Pupil-dilated.
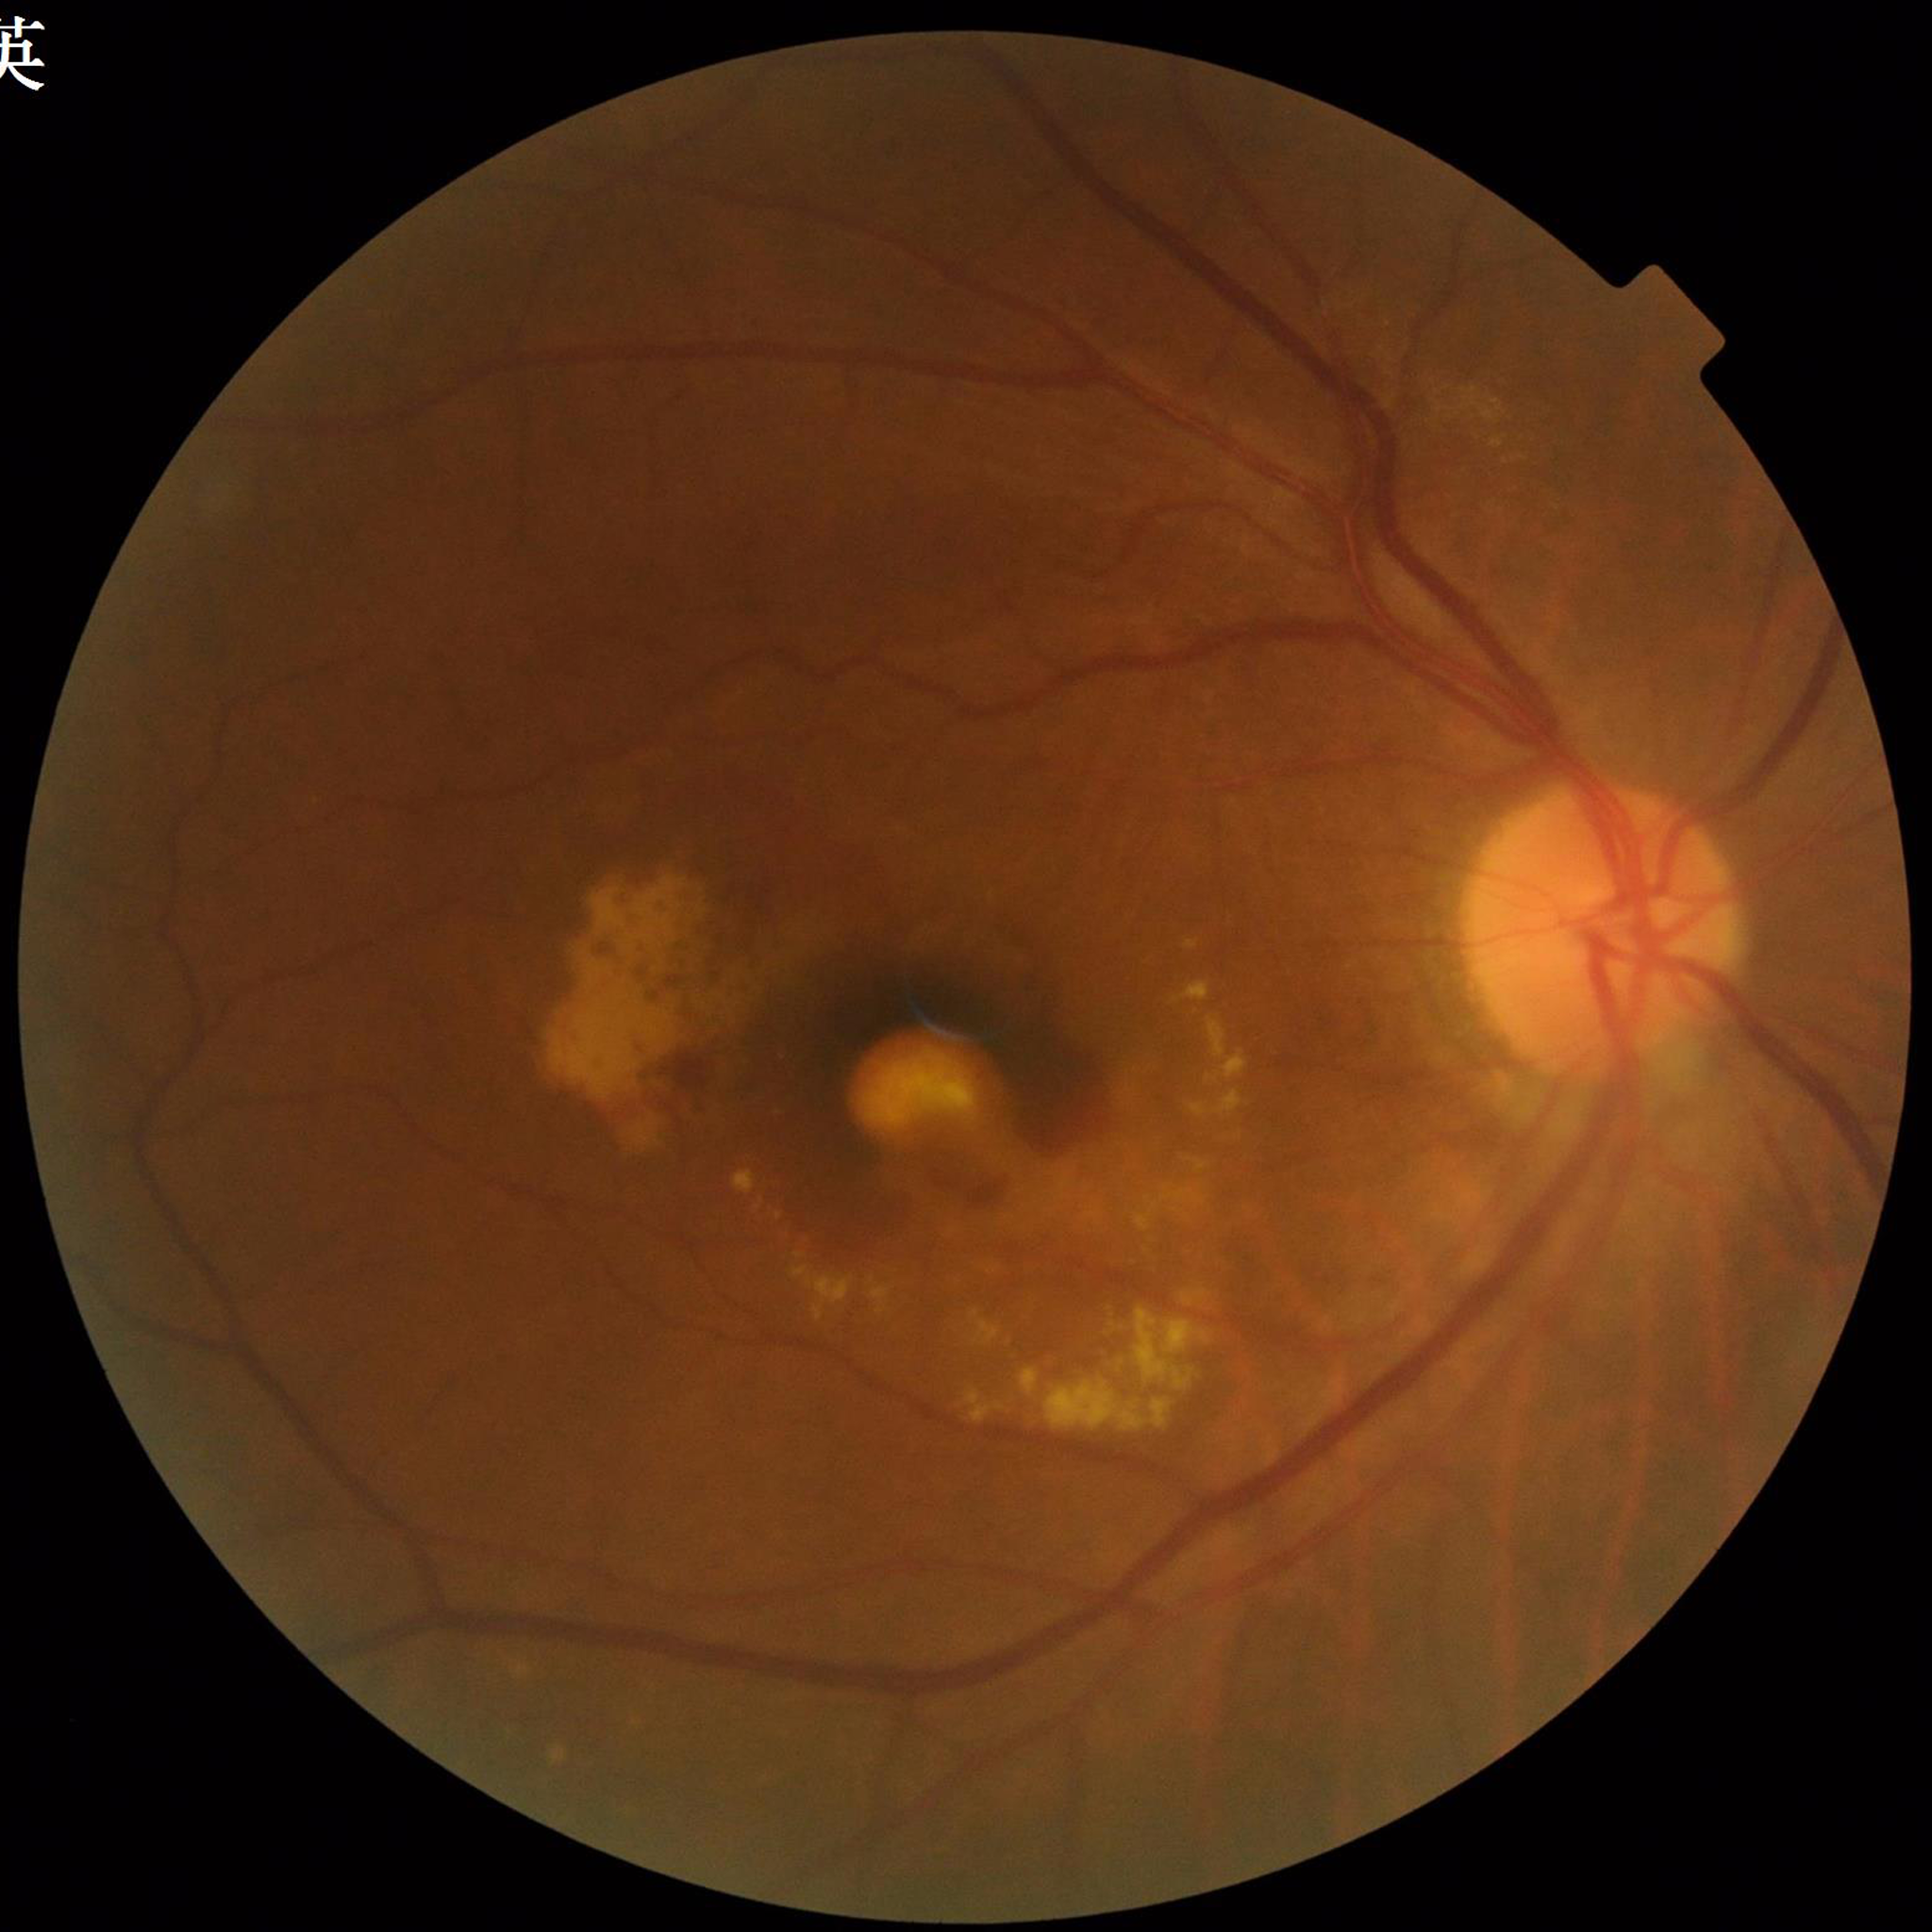 Disease: AMD.